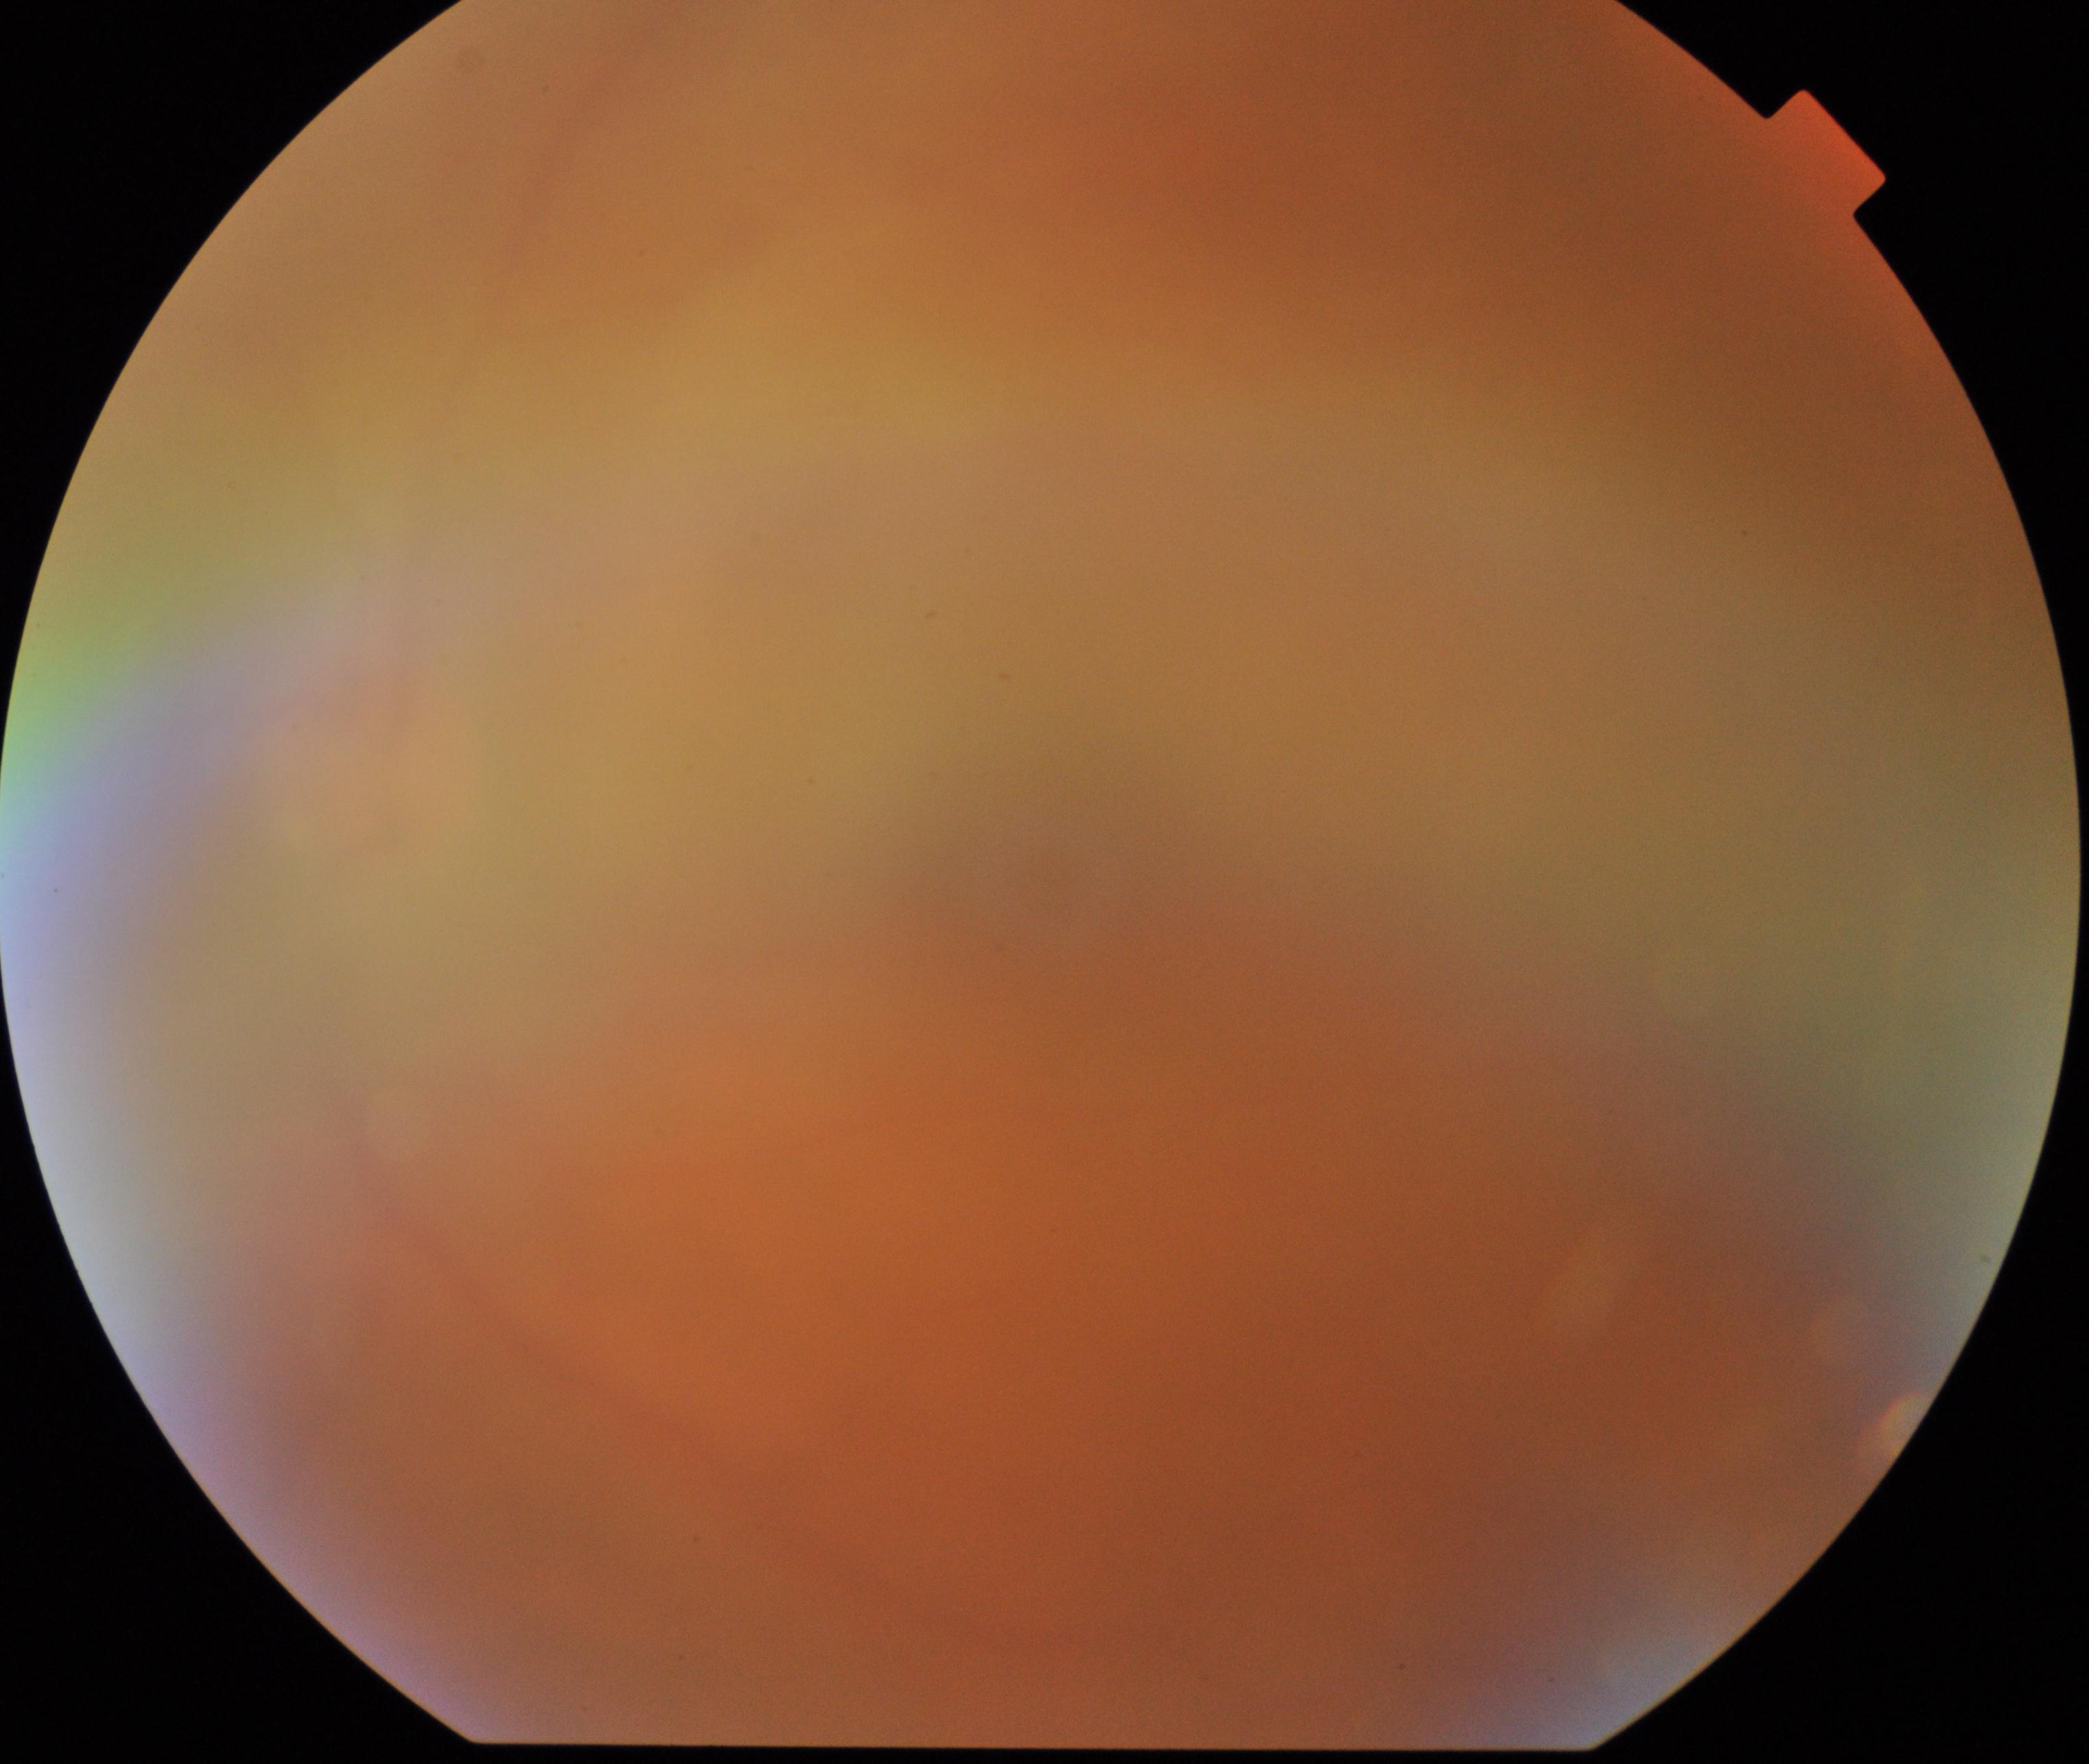
Gradability: poor. Proliferative retinopathy: absent.